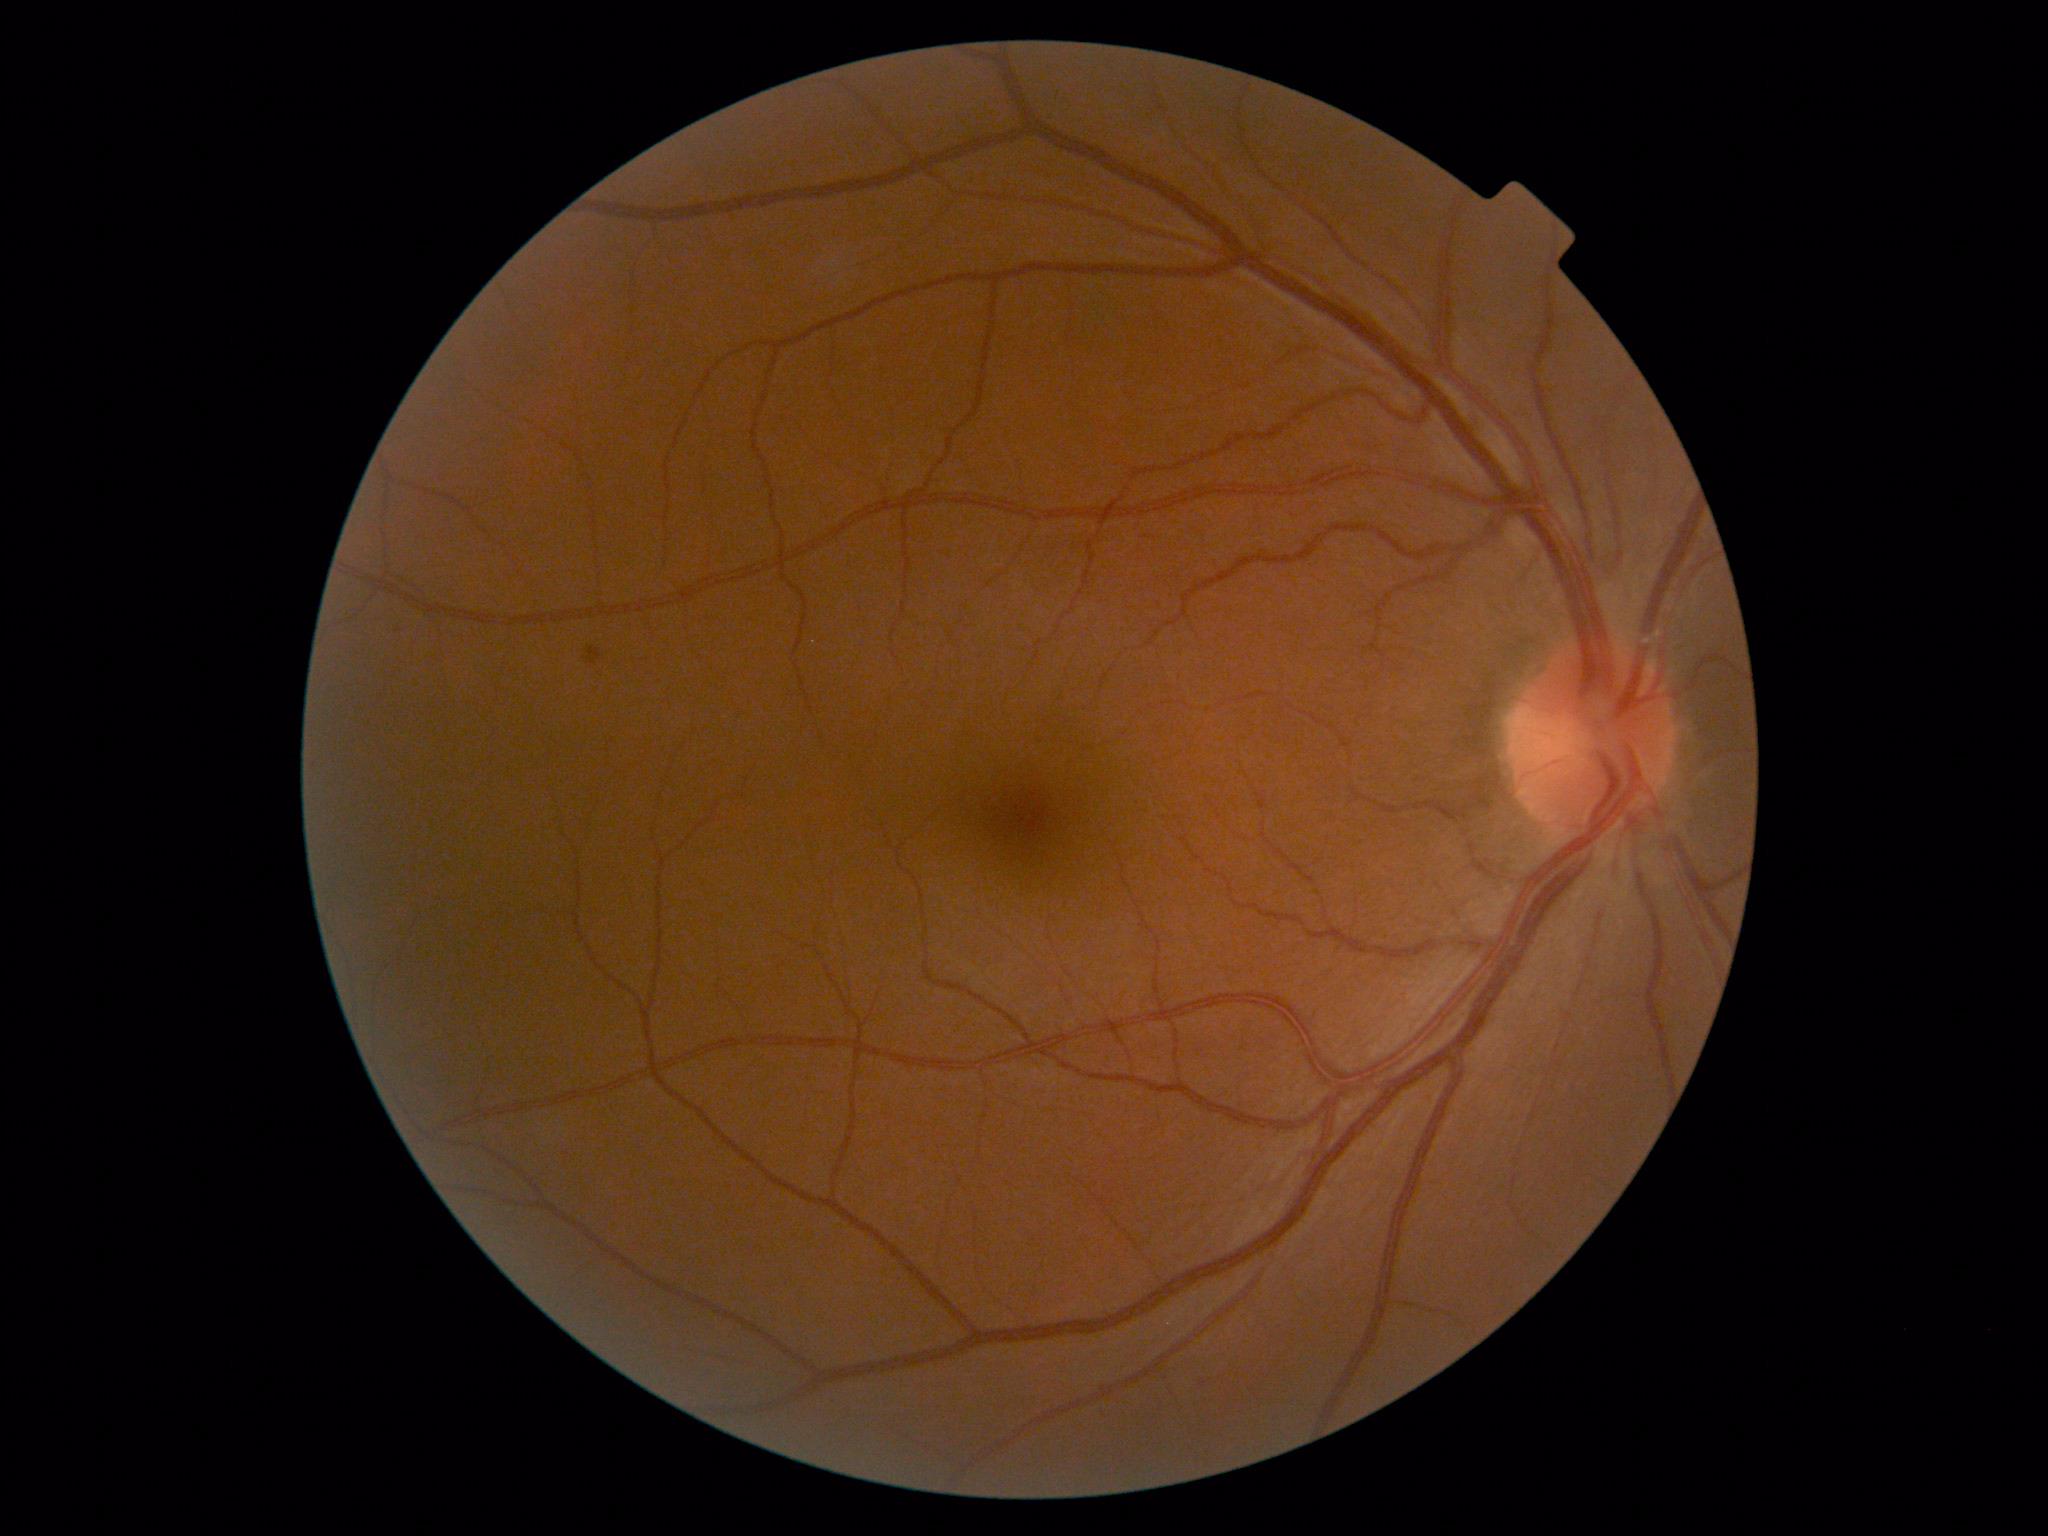 • diabetic retinopathy (DR): grade 2 (moderate NPDR)